Captured with the Natus RetCam Envision (130° field of view); wide-field contact fundus photograph of an infant — 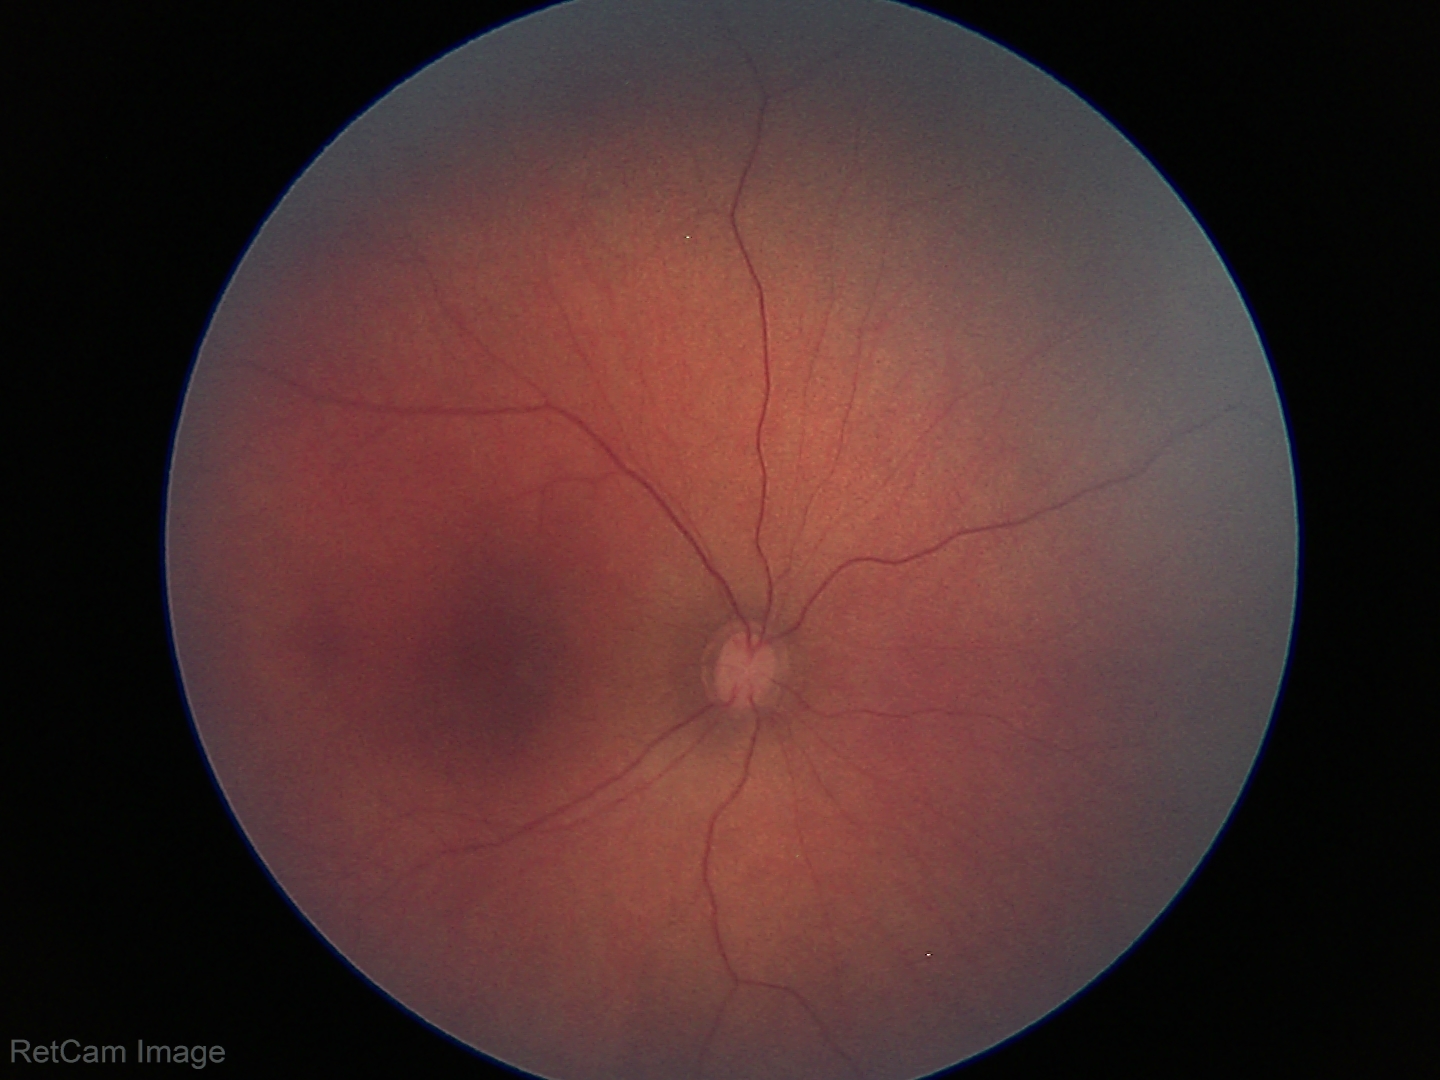 Finding = normal.